45° field of view — 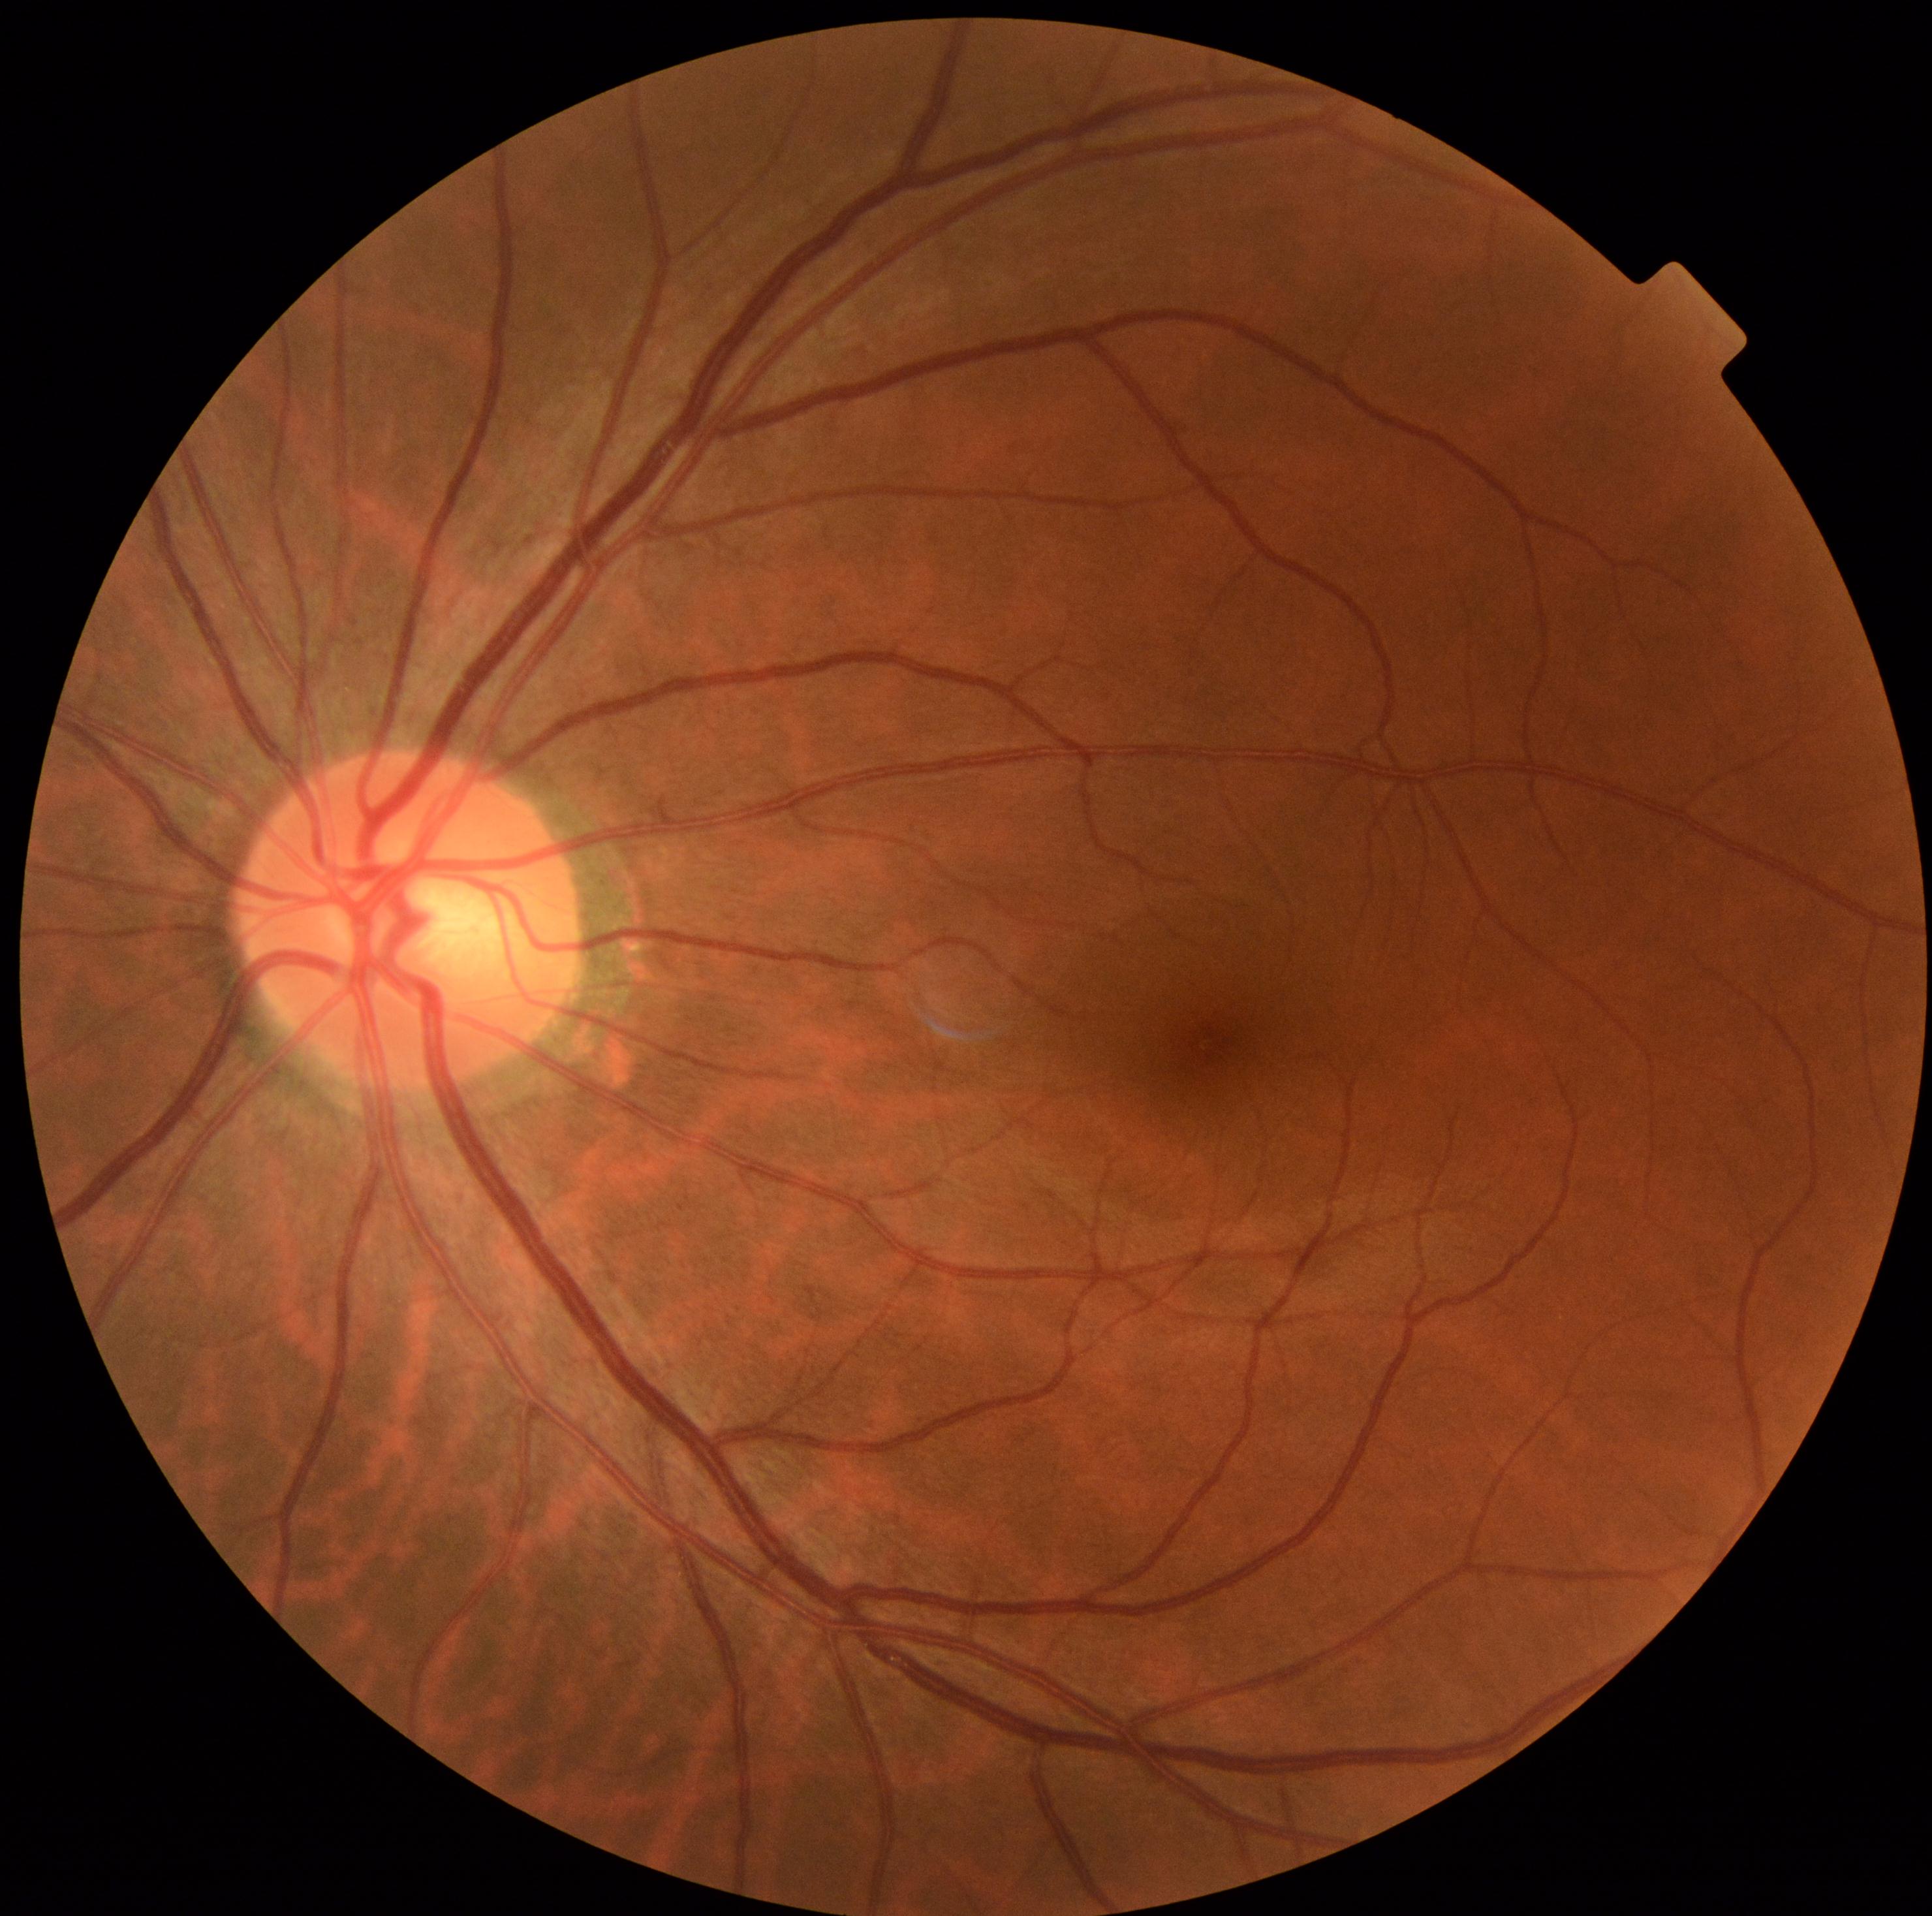
DR is 0.